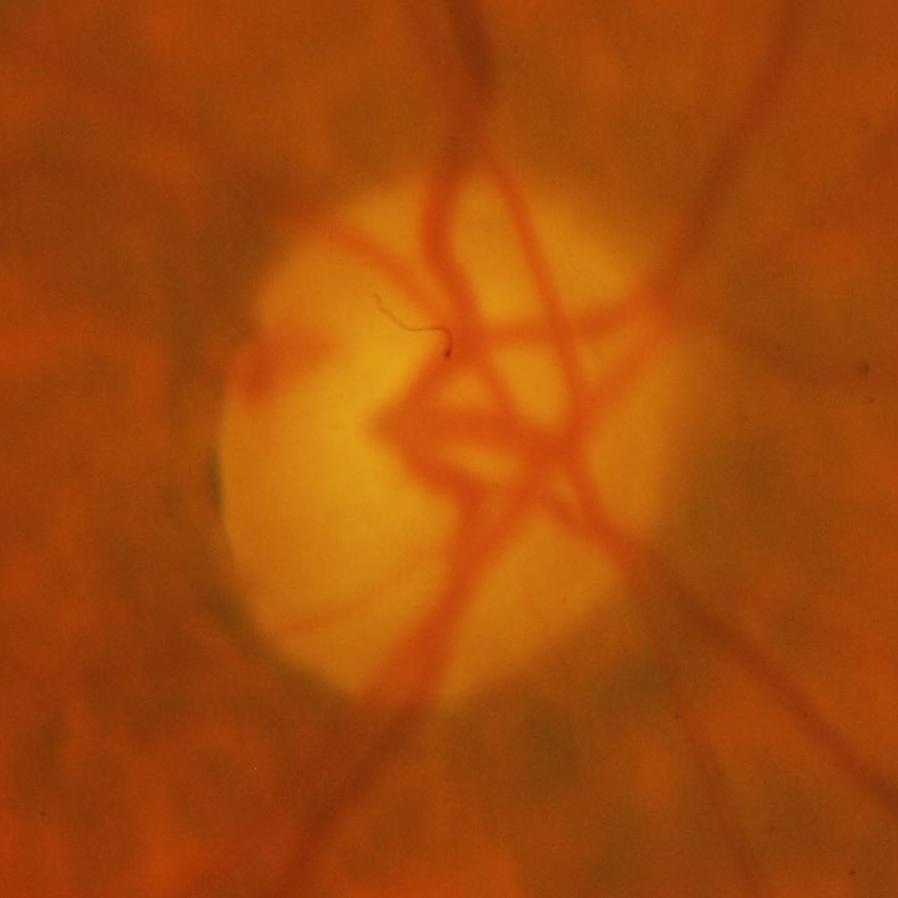 Optic disc appearance consistent with glaucomatous damage to the optic nerve.